45° FOV.
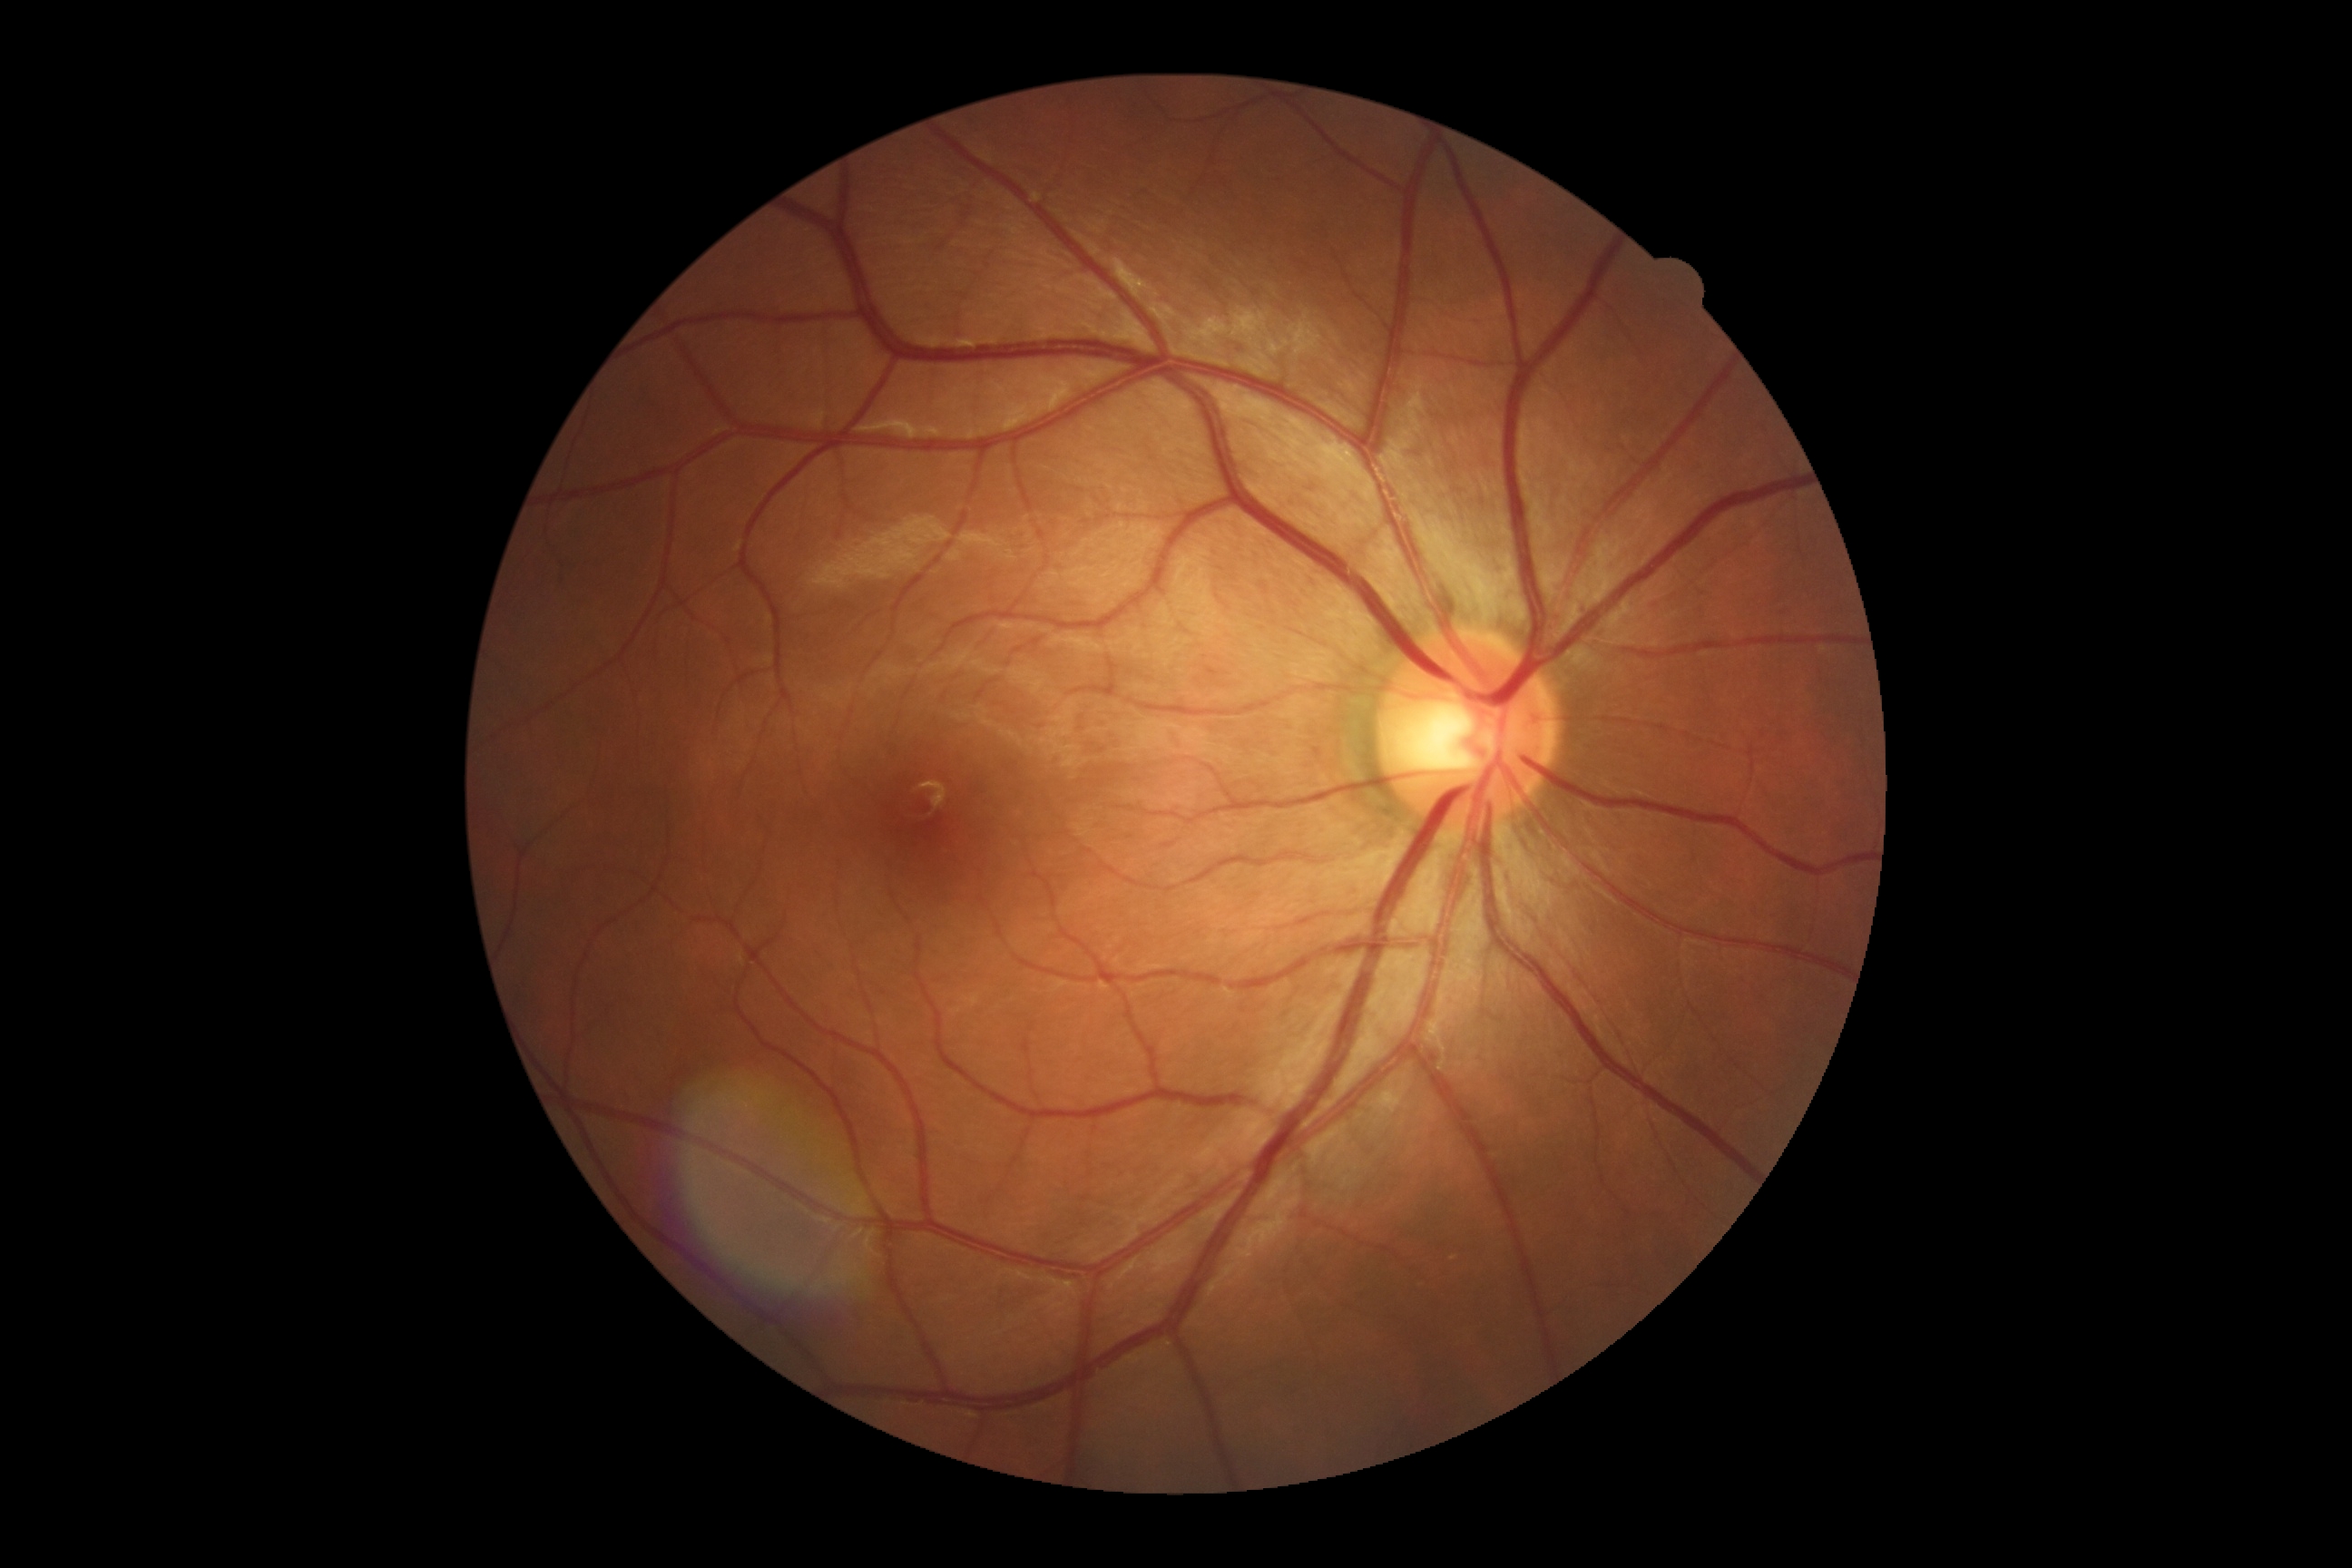
DR stage = no apparent retinopathy (grade 0).